Color fundus photograph. 2089 x 1764 pixels
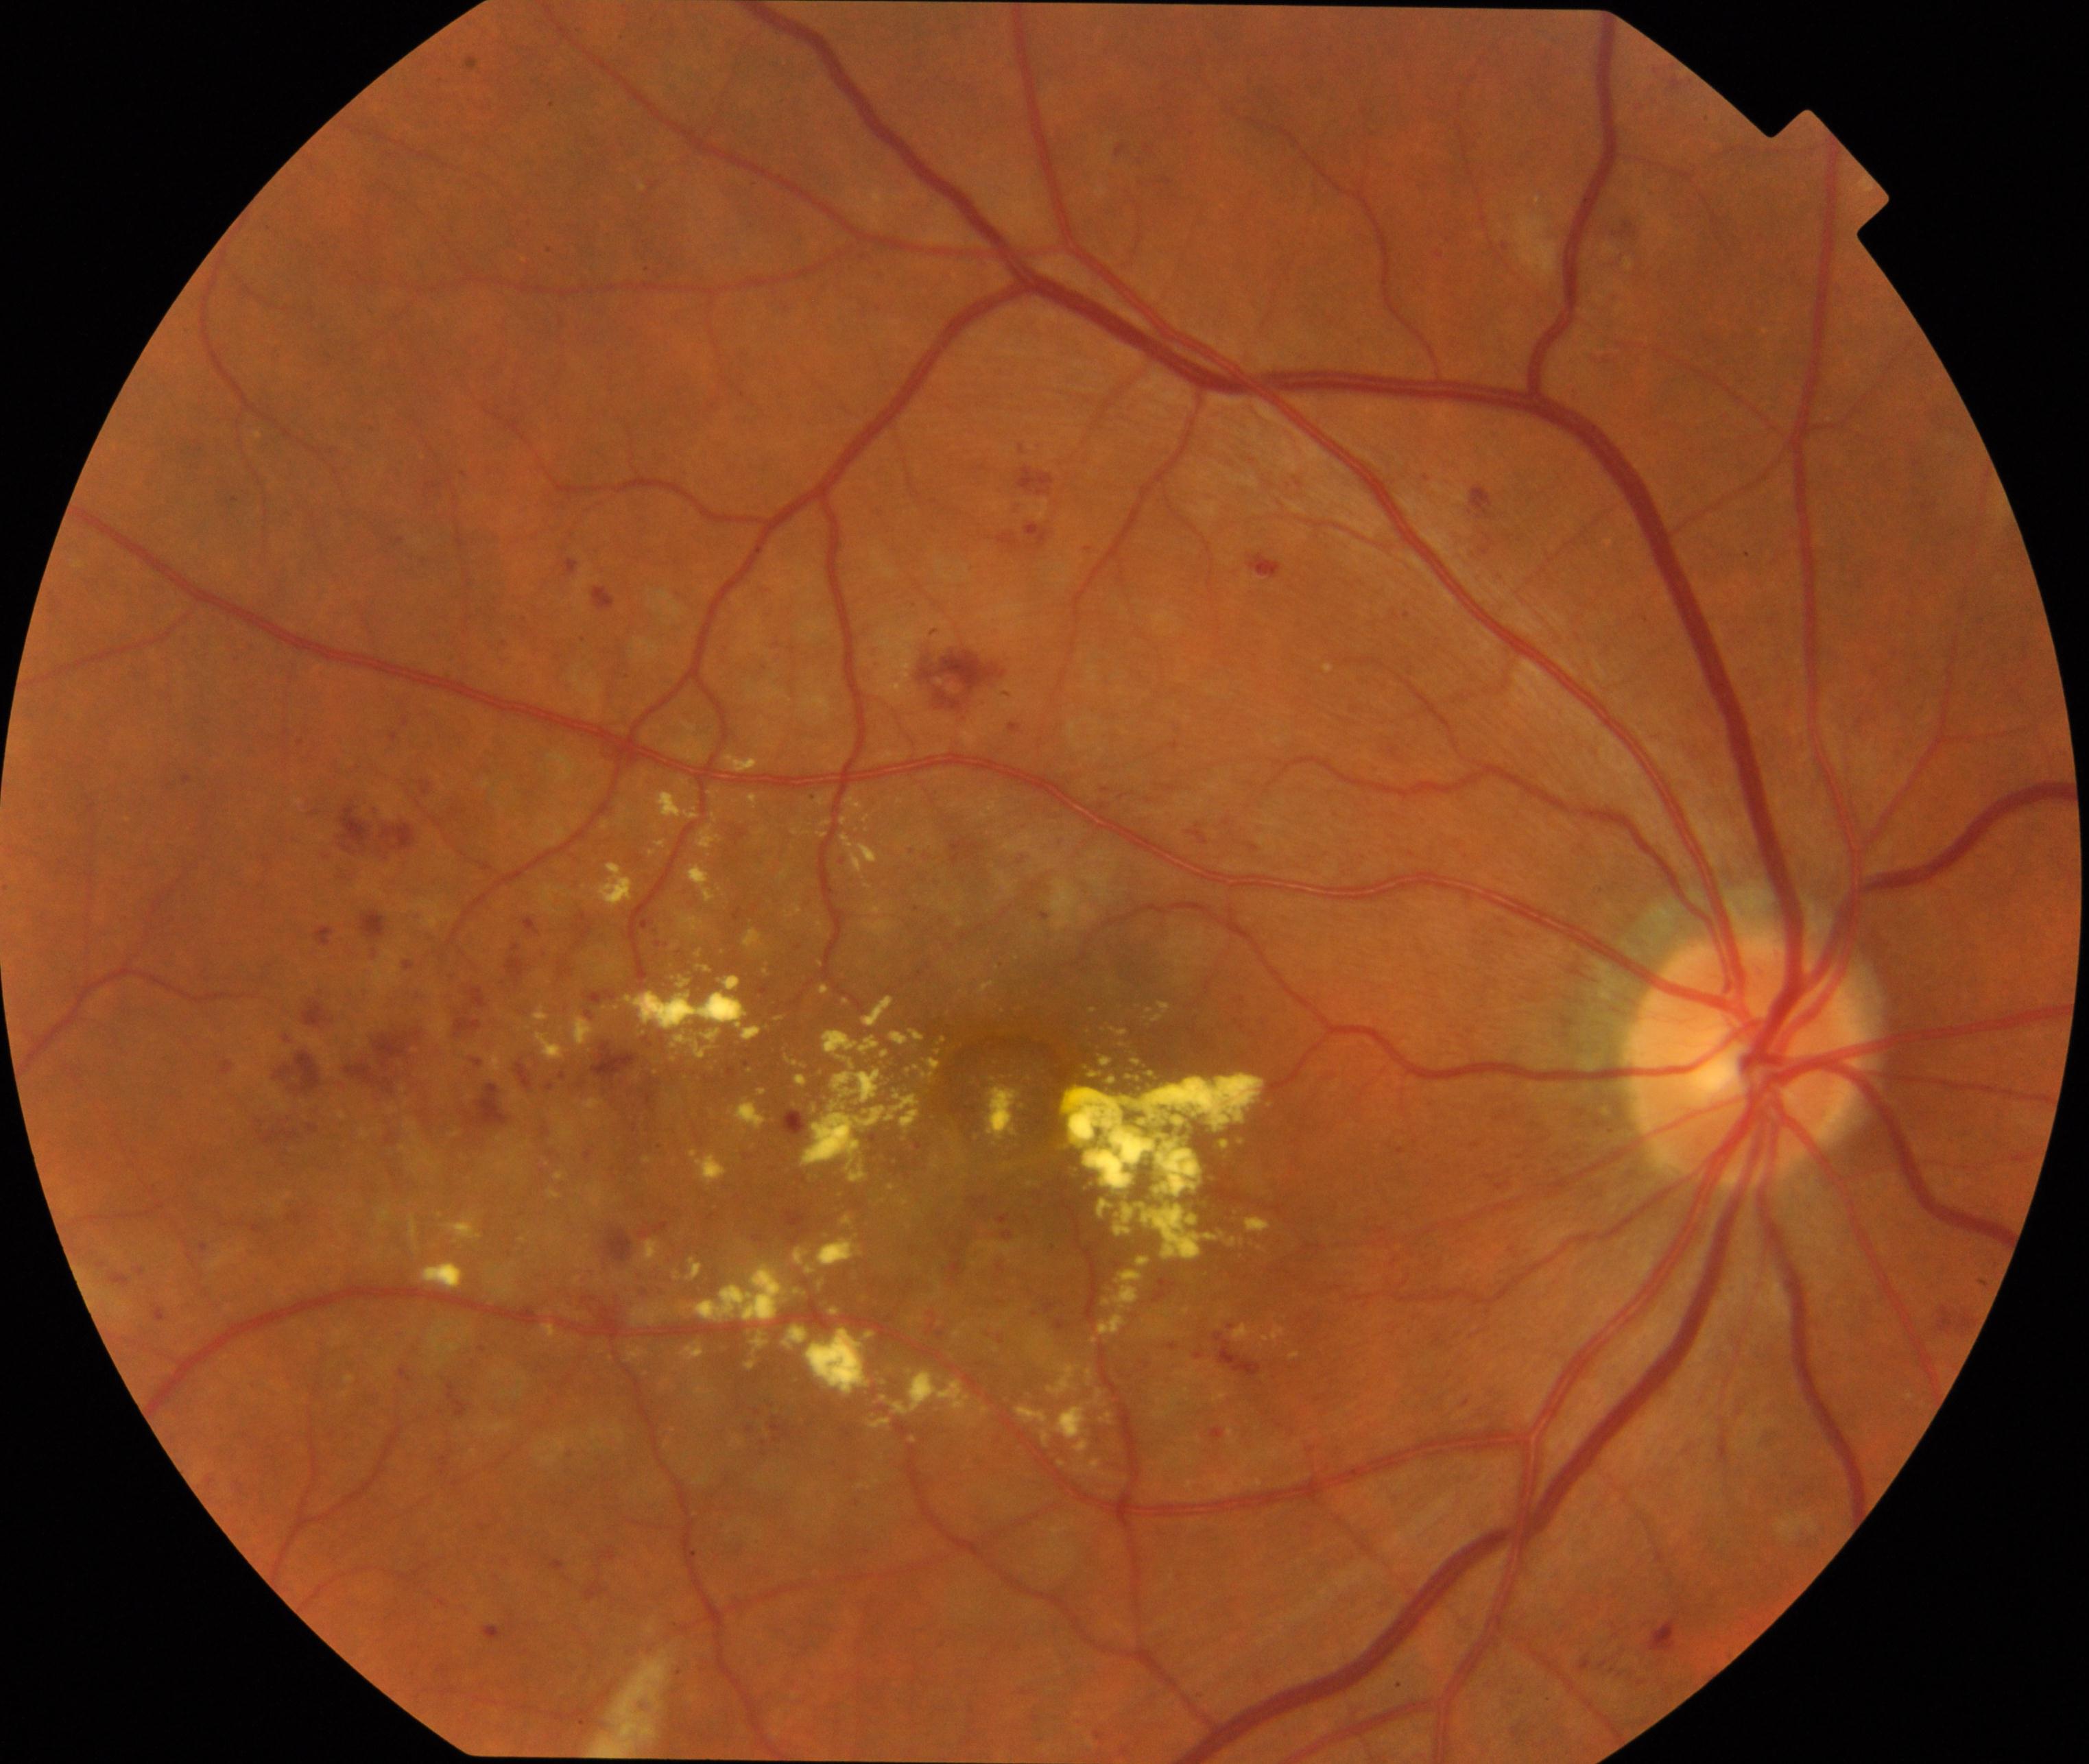
Classification: moderate non-proliferative diabetic retinopathy. Defined by microaneurysms with dot and blot hemorrhages or hard exudates, less than severe non-proliferative diabetic retinopathy, and/or with diabetic macular edema.